Retinal fundus photograph: 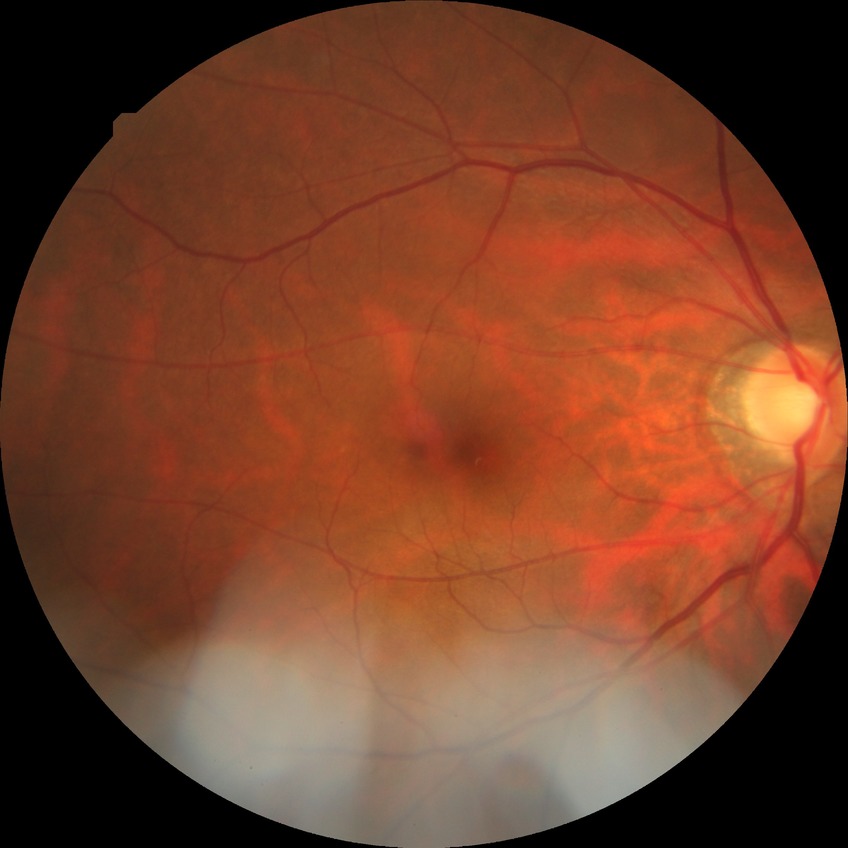
Davis grade = NDR.